2212 x 1659 pixels
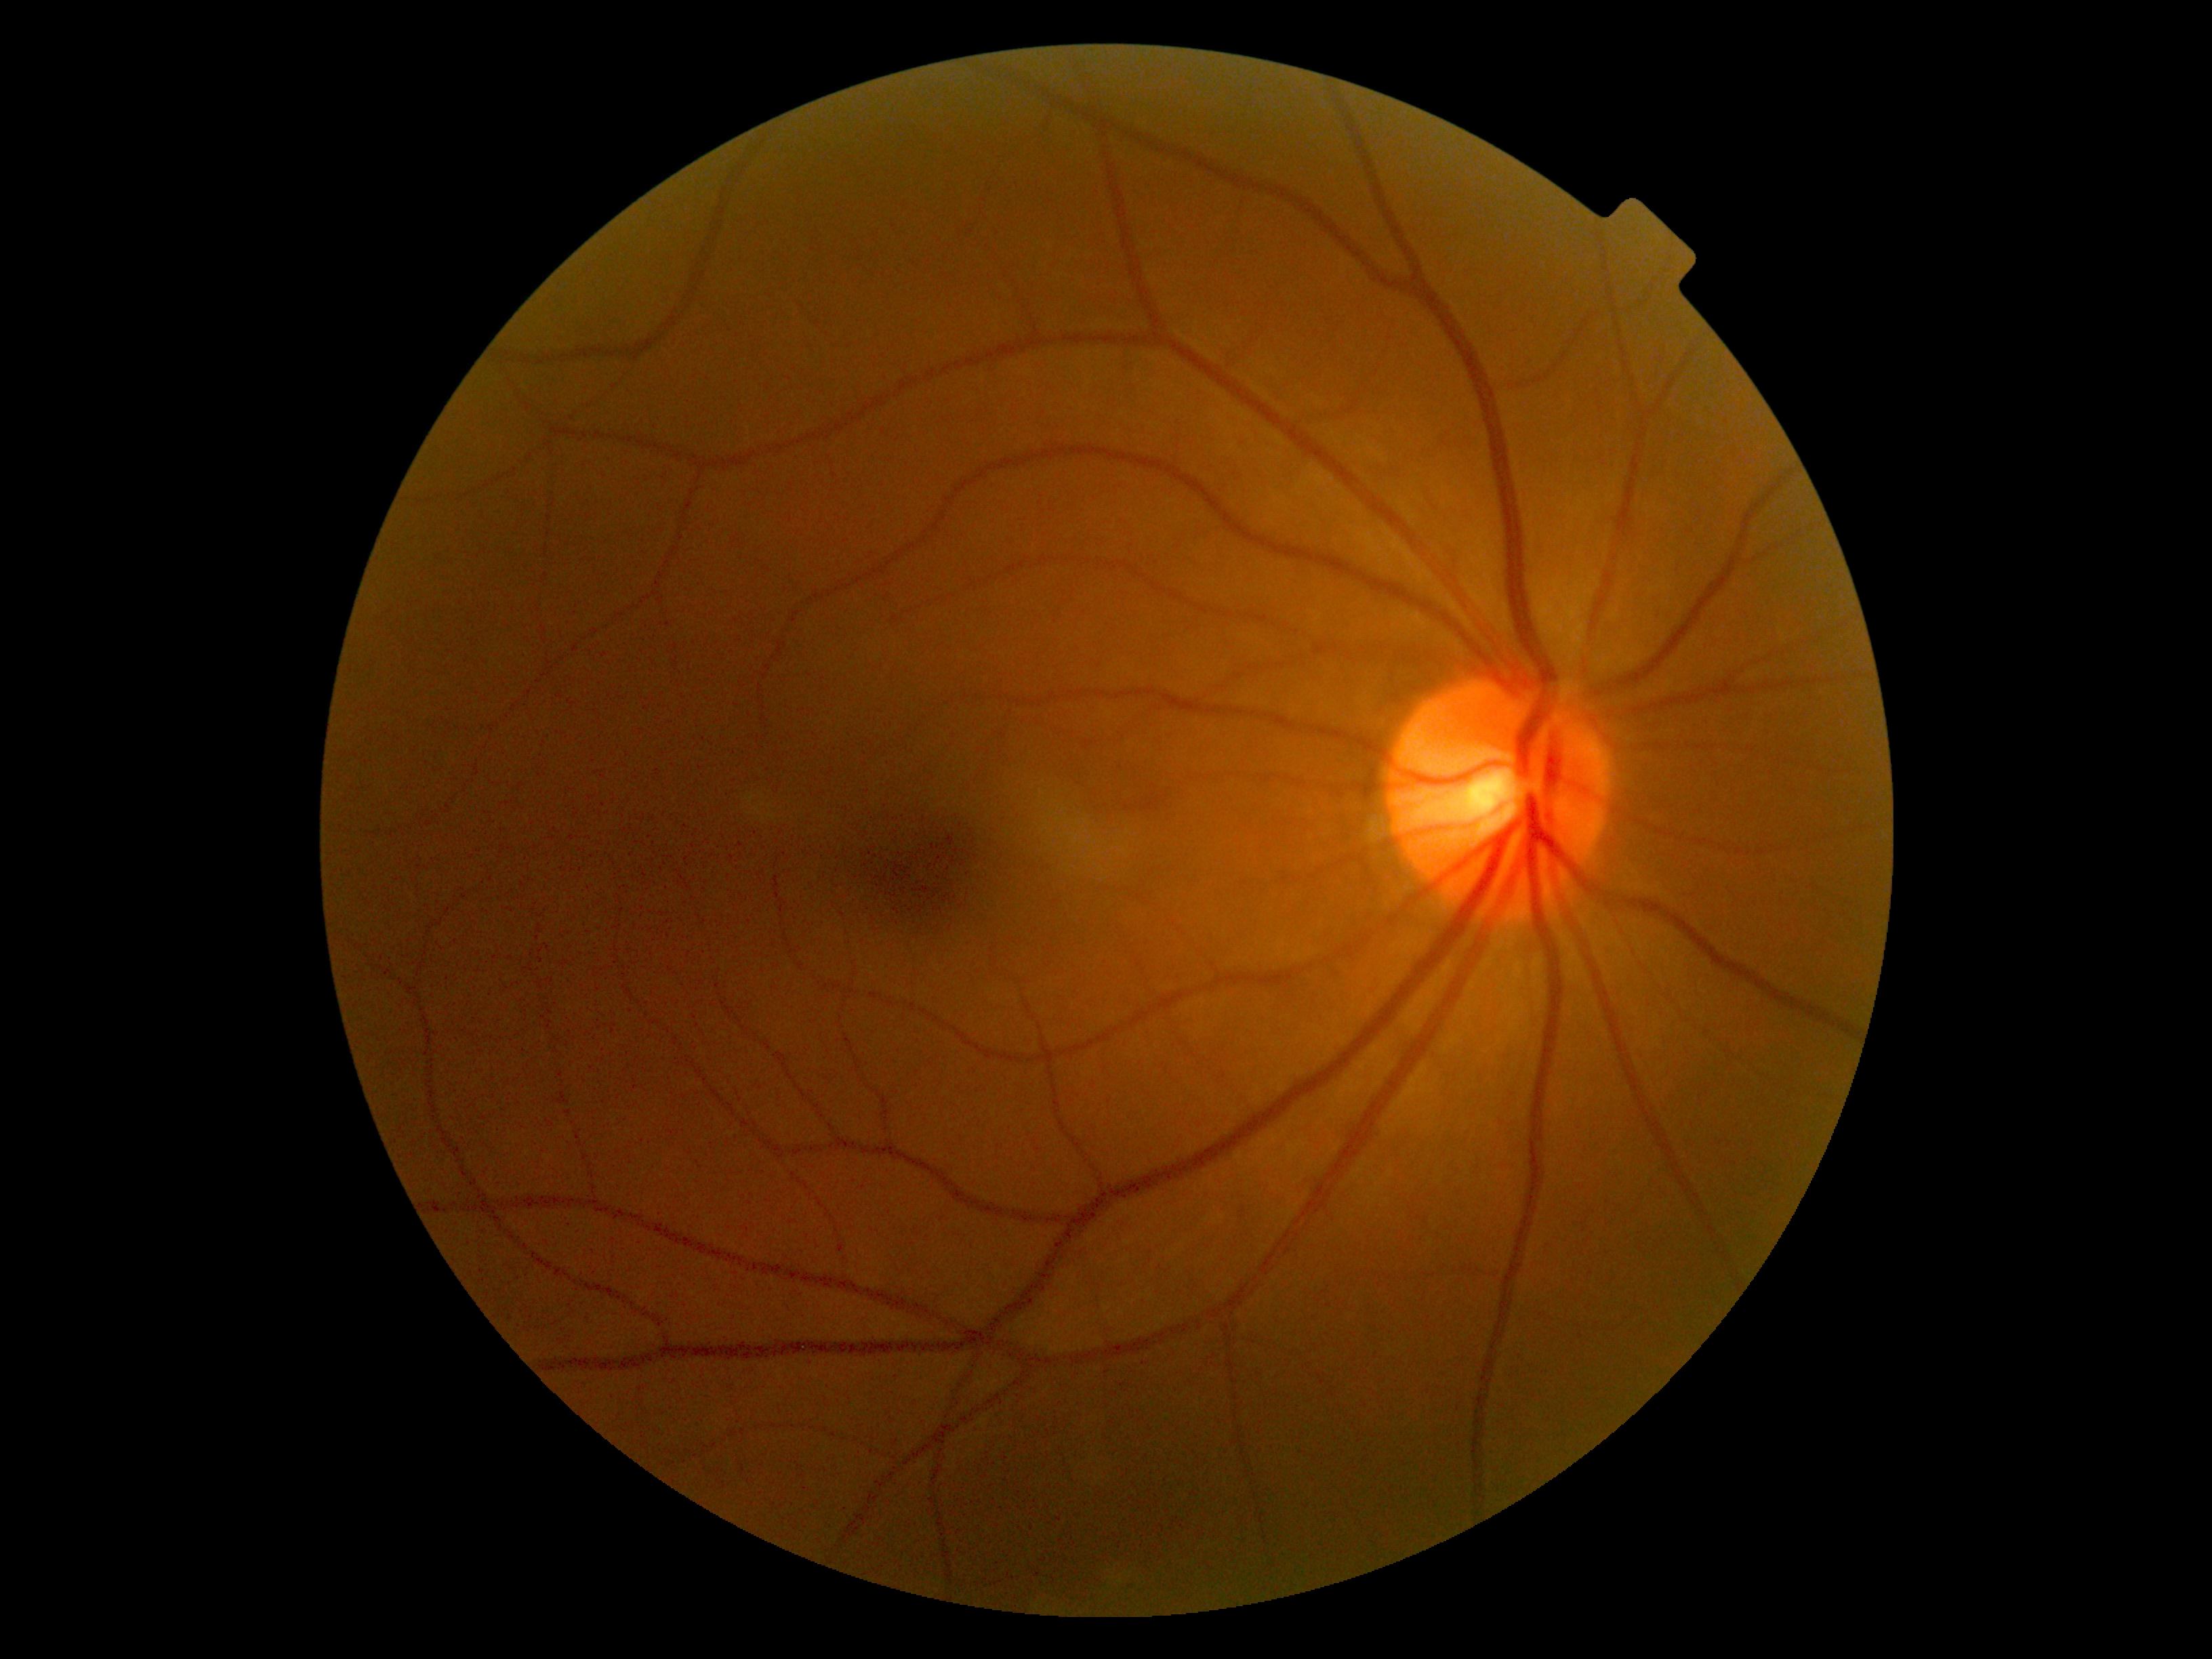

No apparent diabetic retinopathy.
Diabetic retinopathy grade is 0 (no apparent retinopathy).